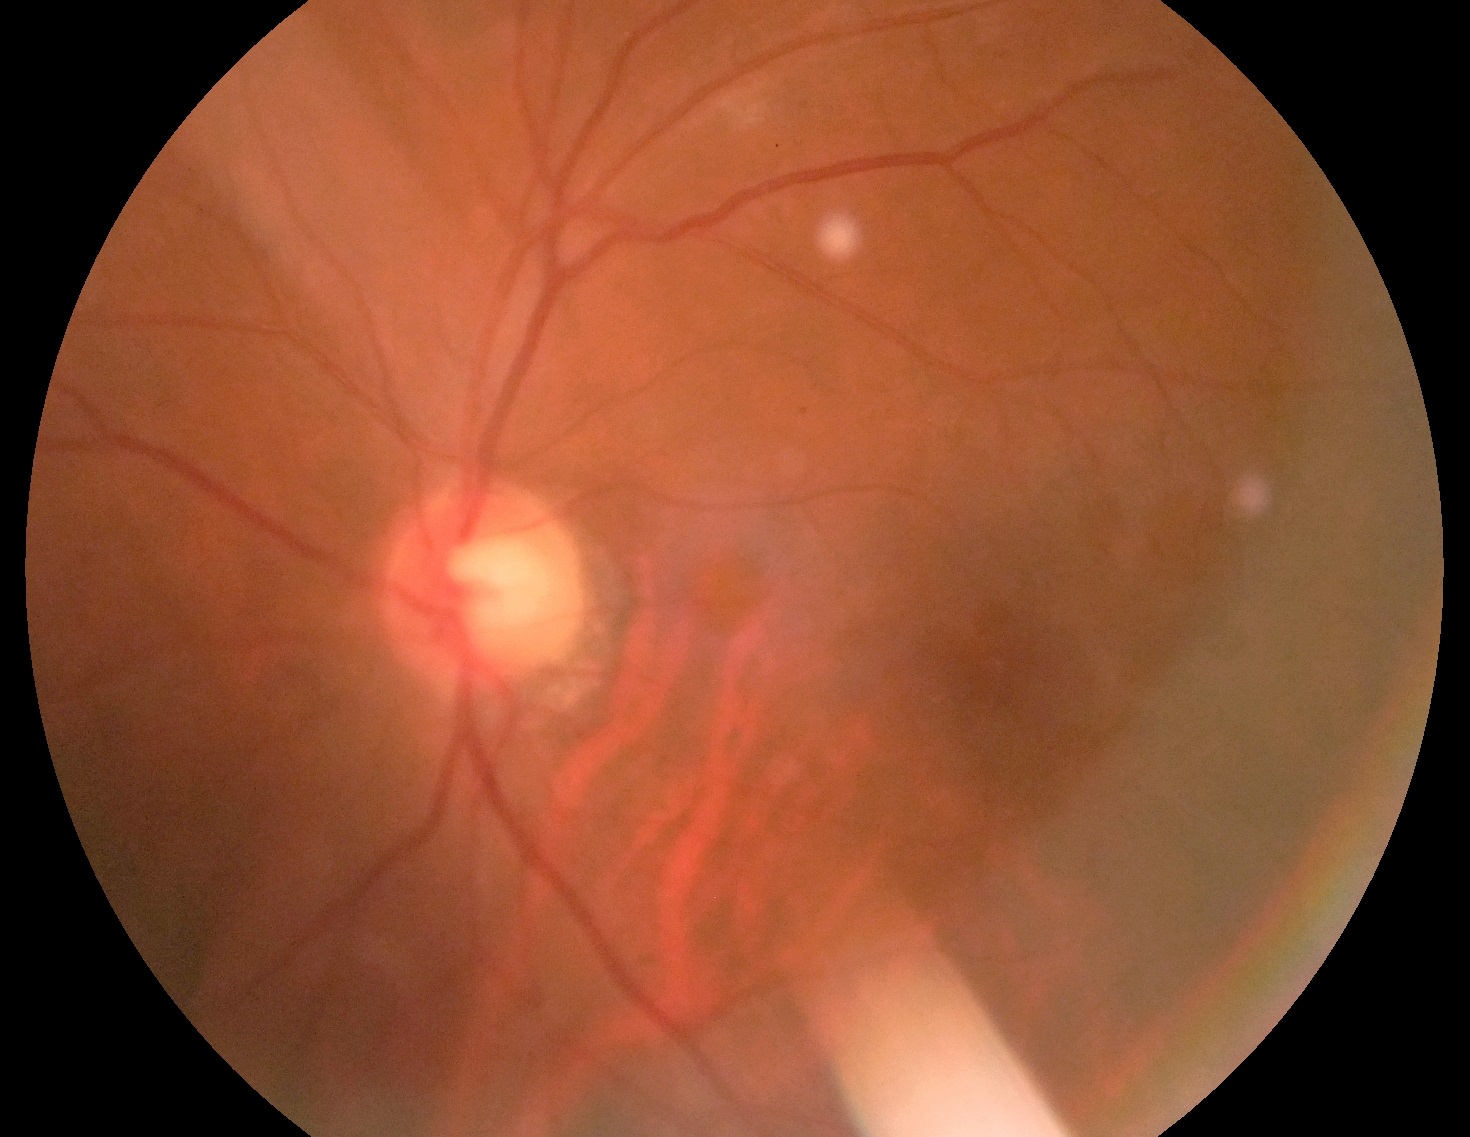

diabetic retinopathy (DR): grade 0 (no apparent retinopathy)